FOV: 45 degrees. 1380x1382px:
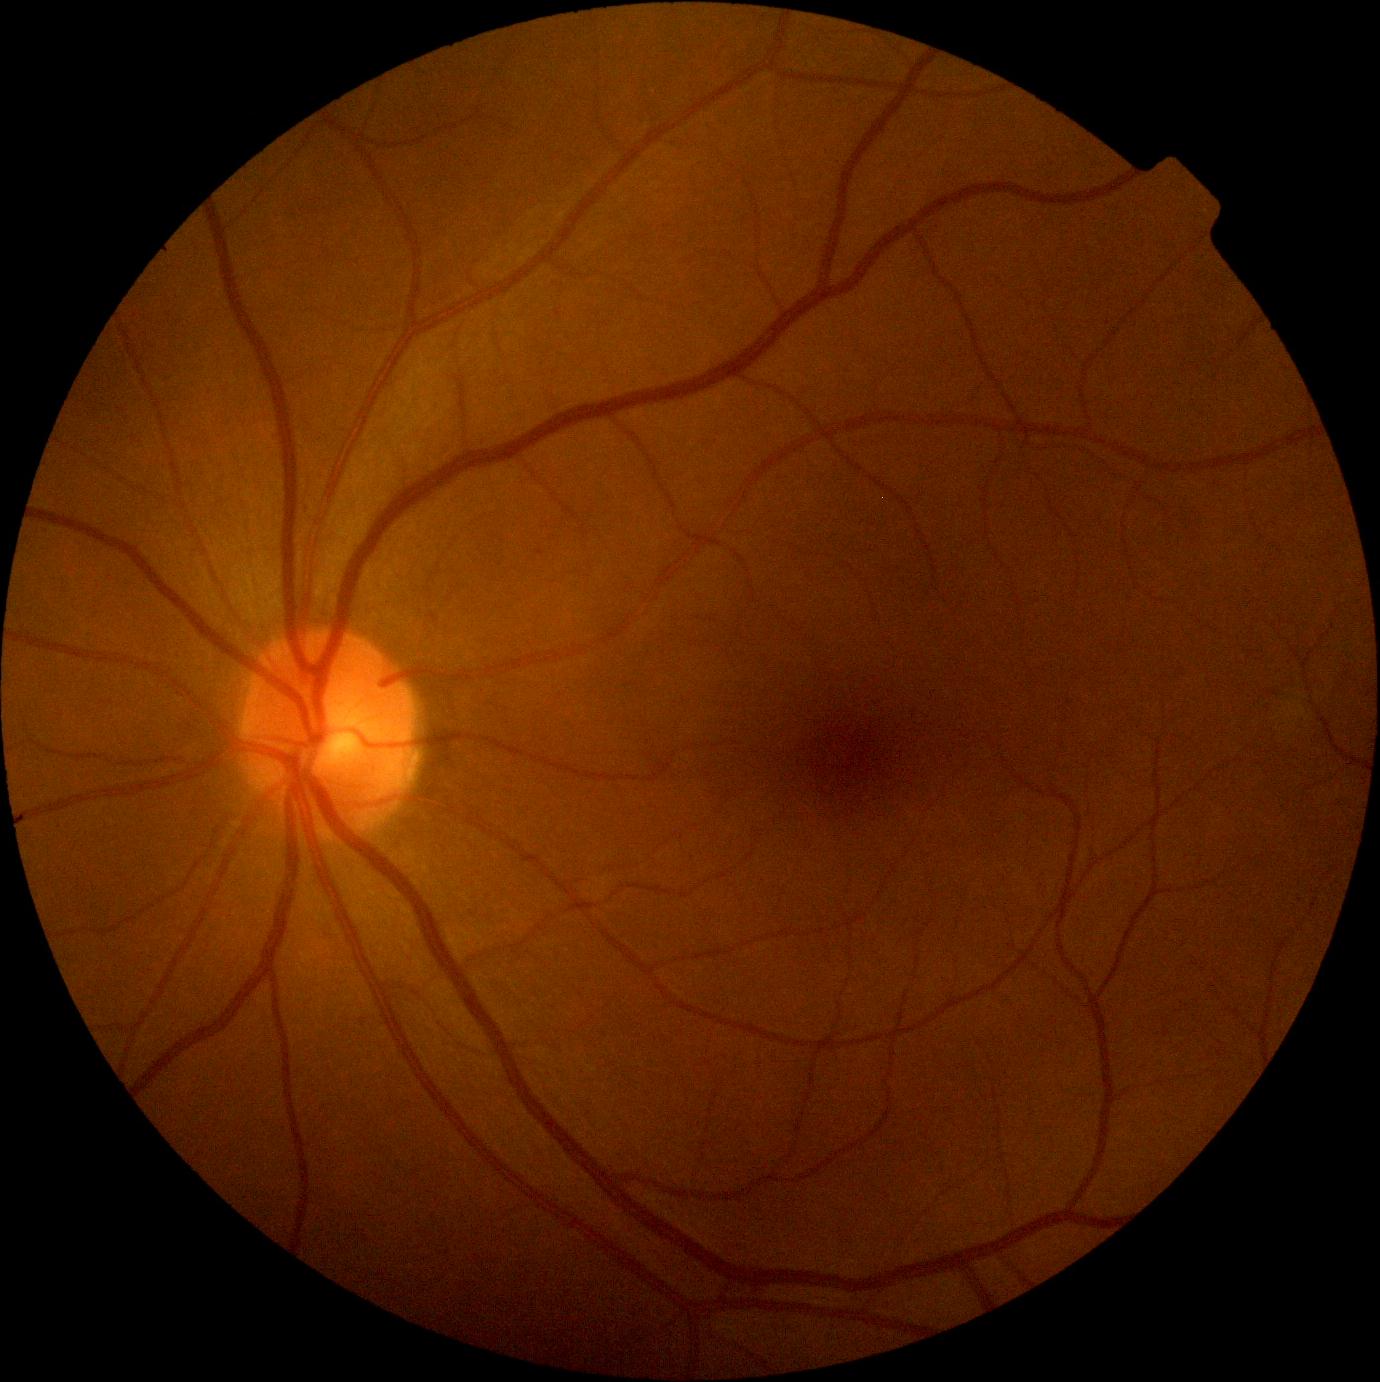
{
  "dr_grade": "grade 1 (mild NPDR)"
}